Nonmydriatic fundus photograph; 45° FOV; NIDEK AFC-230; 848x848 — 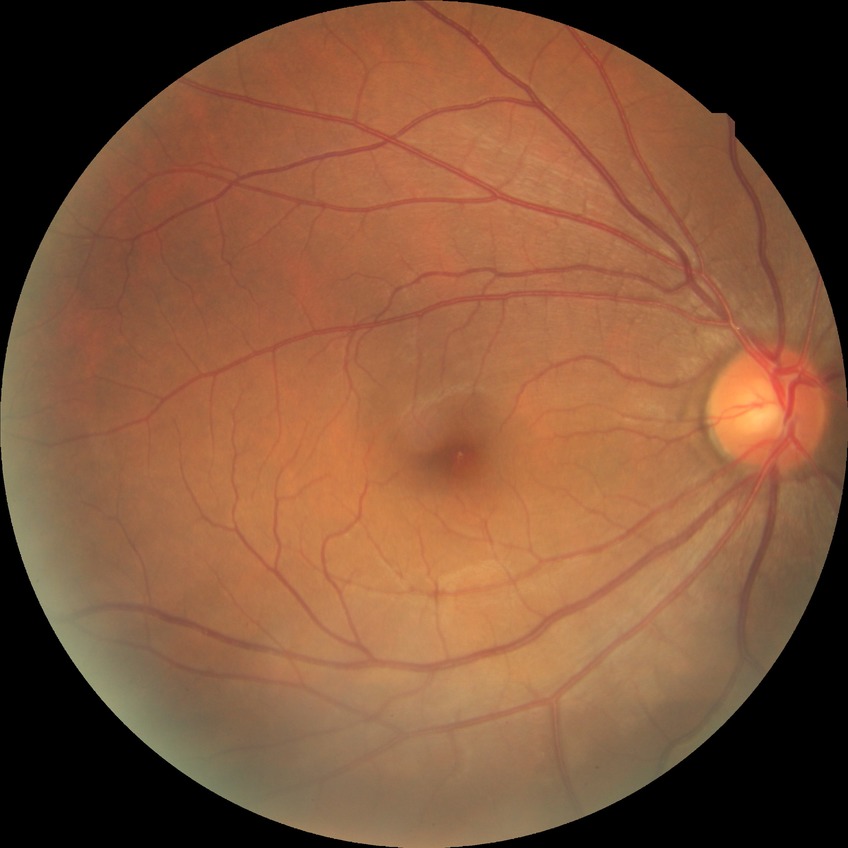 Diabetic retinopathy (DR) is no diabetic retinopathy (NDR).